2361x1568, FOV: 50 degrees, retinal fundus photograph.
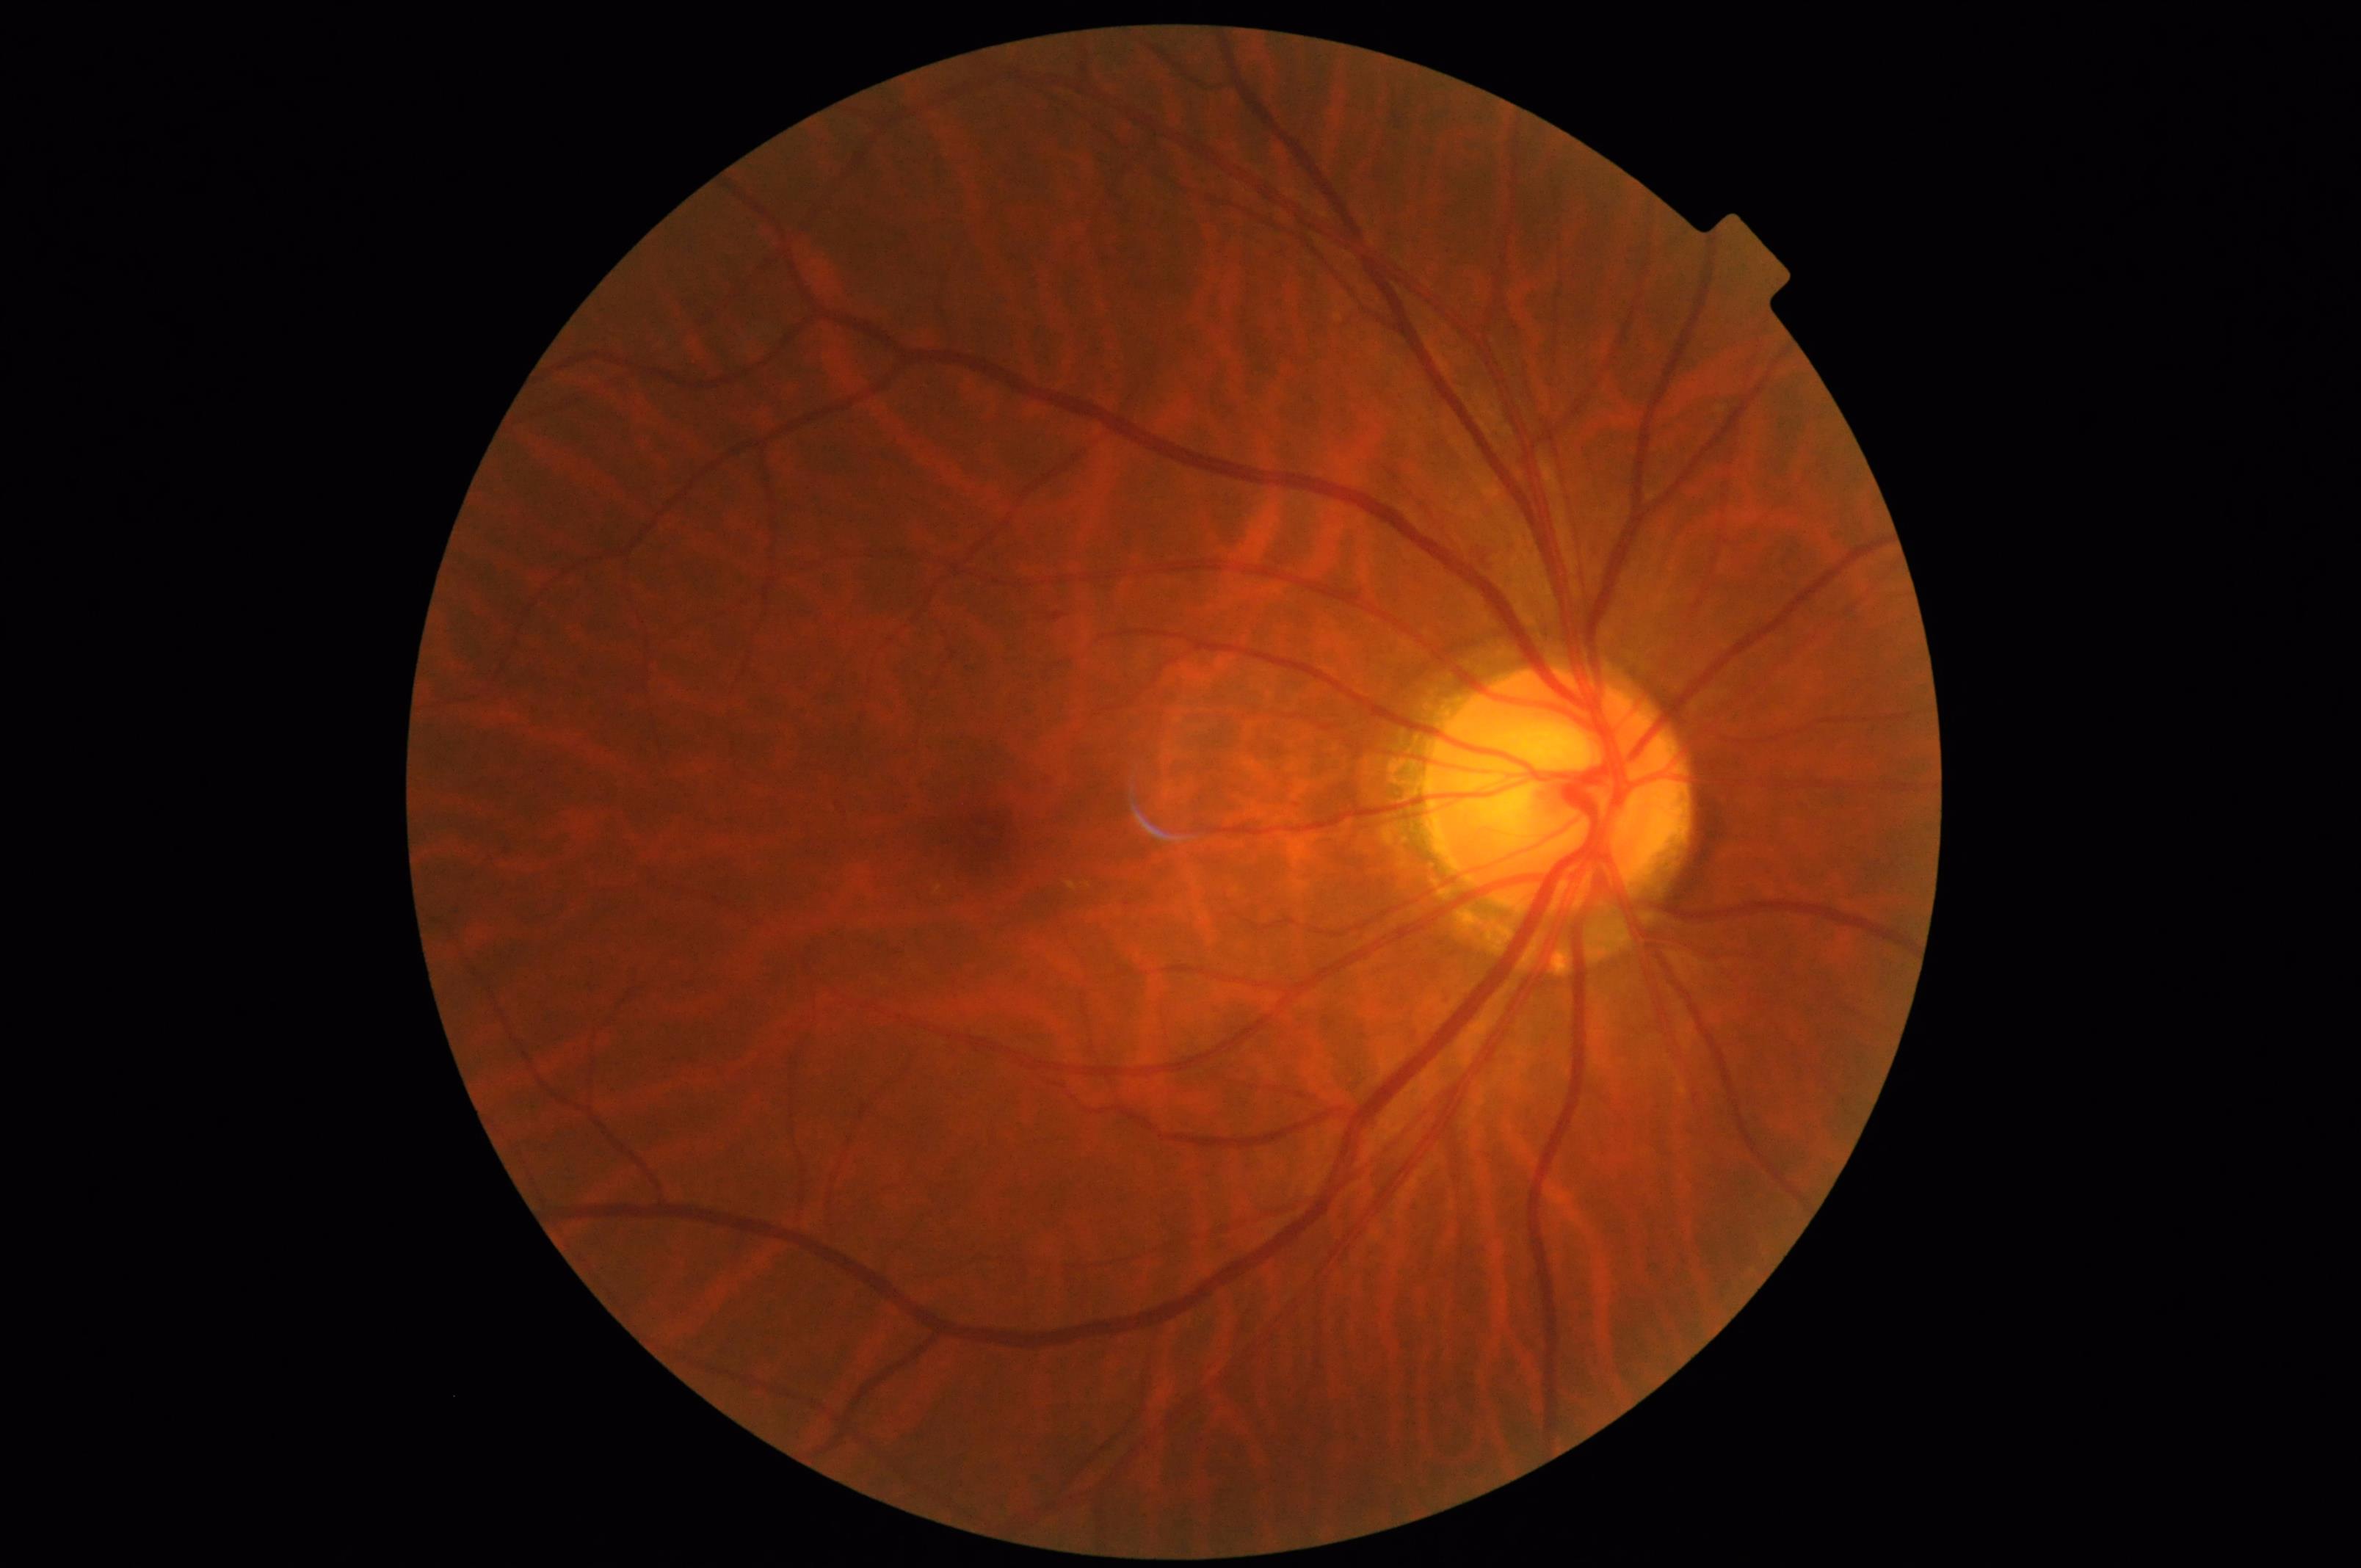 No over- or under-exposure. Image is sharp throughout the field. Vessels and details are readily distinguishable. Overall quality is good and the image is gradable.